2212 x 1659 pixels, 45° field of view, retinal fundus photograph:
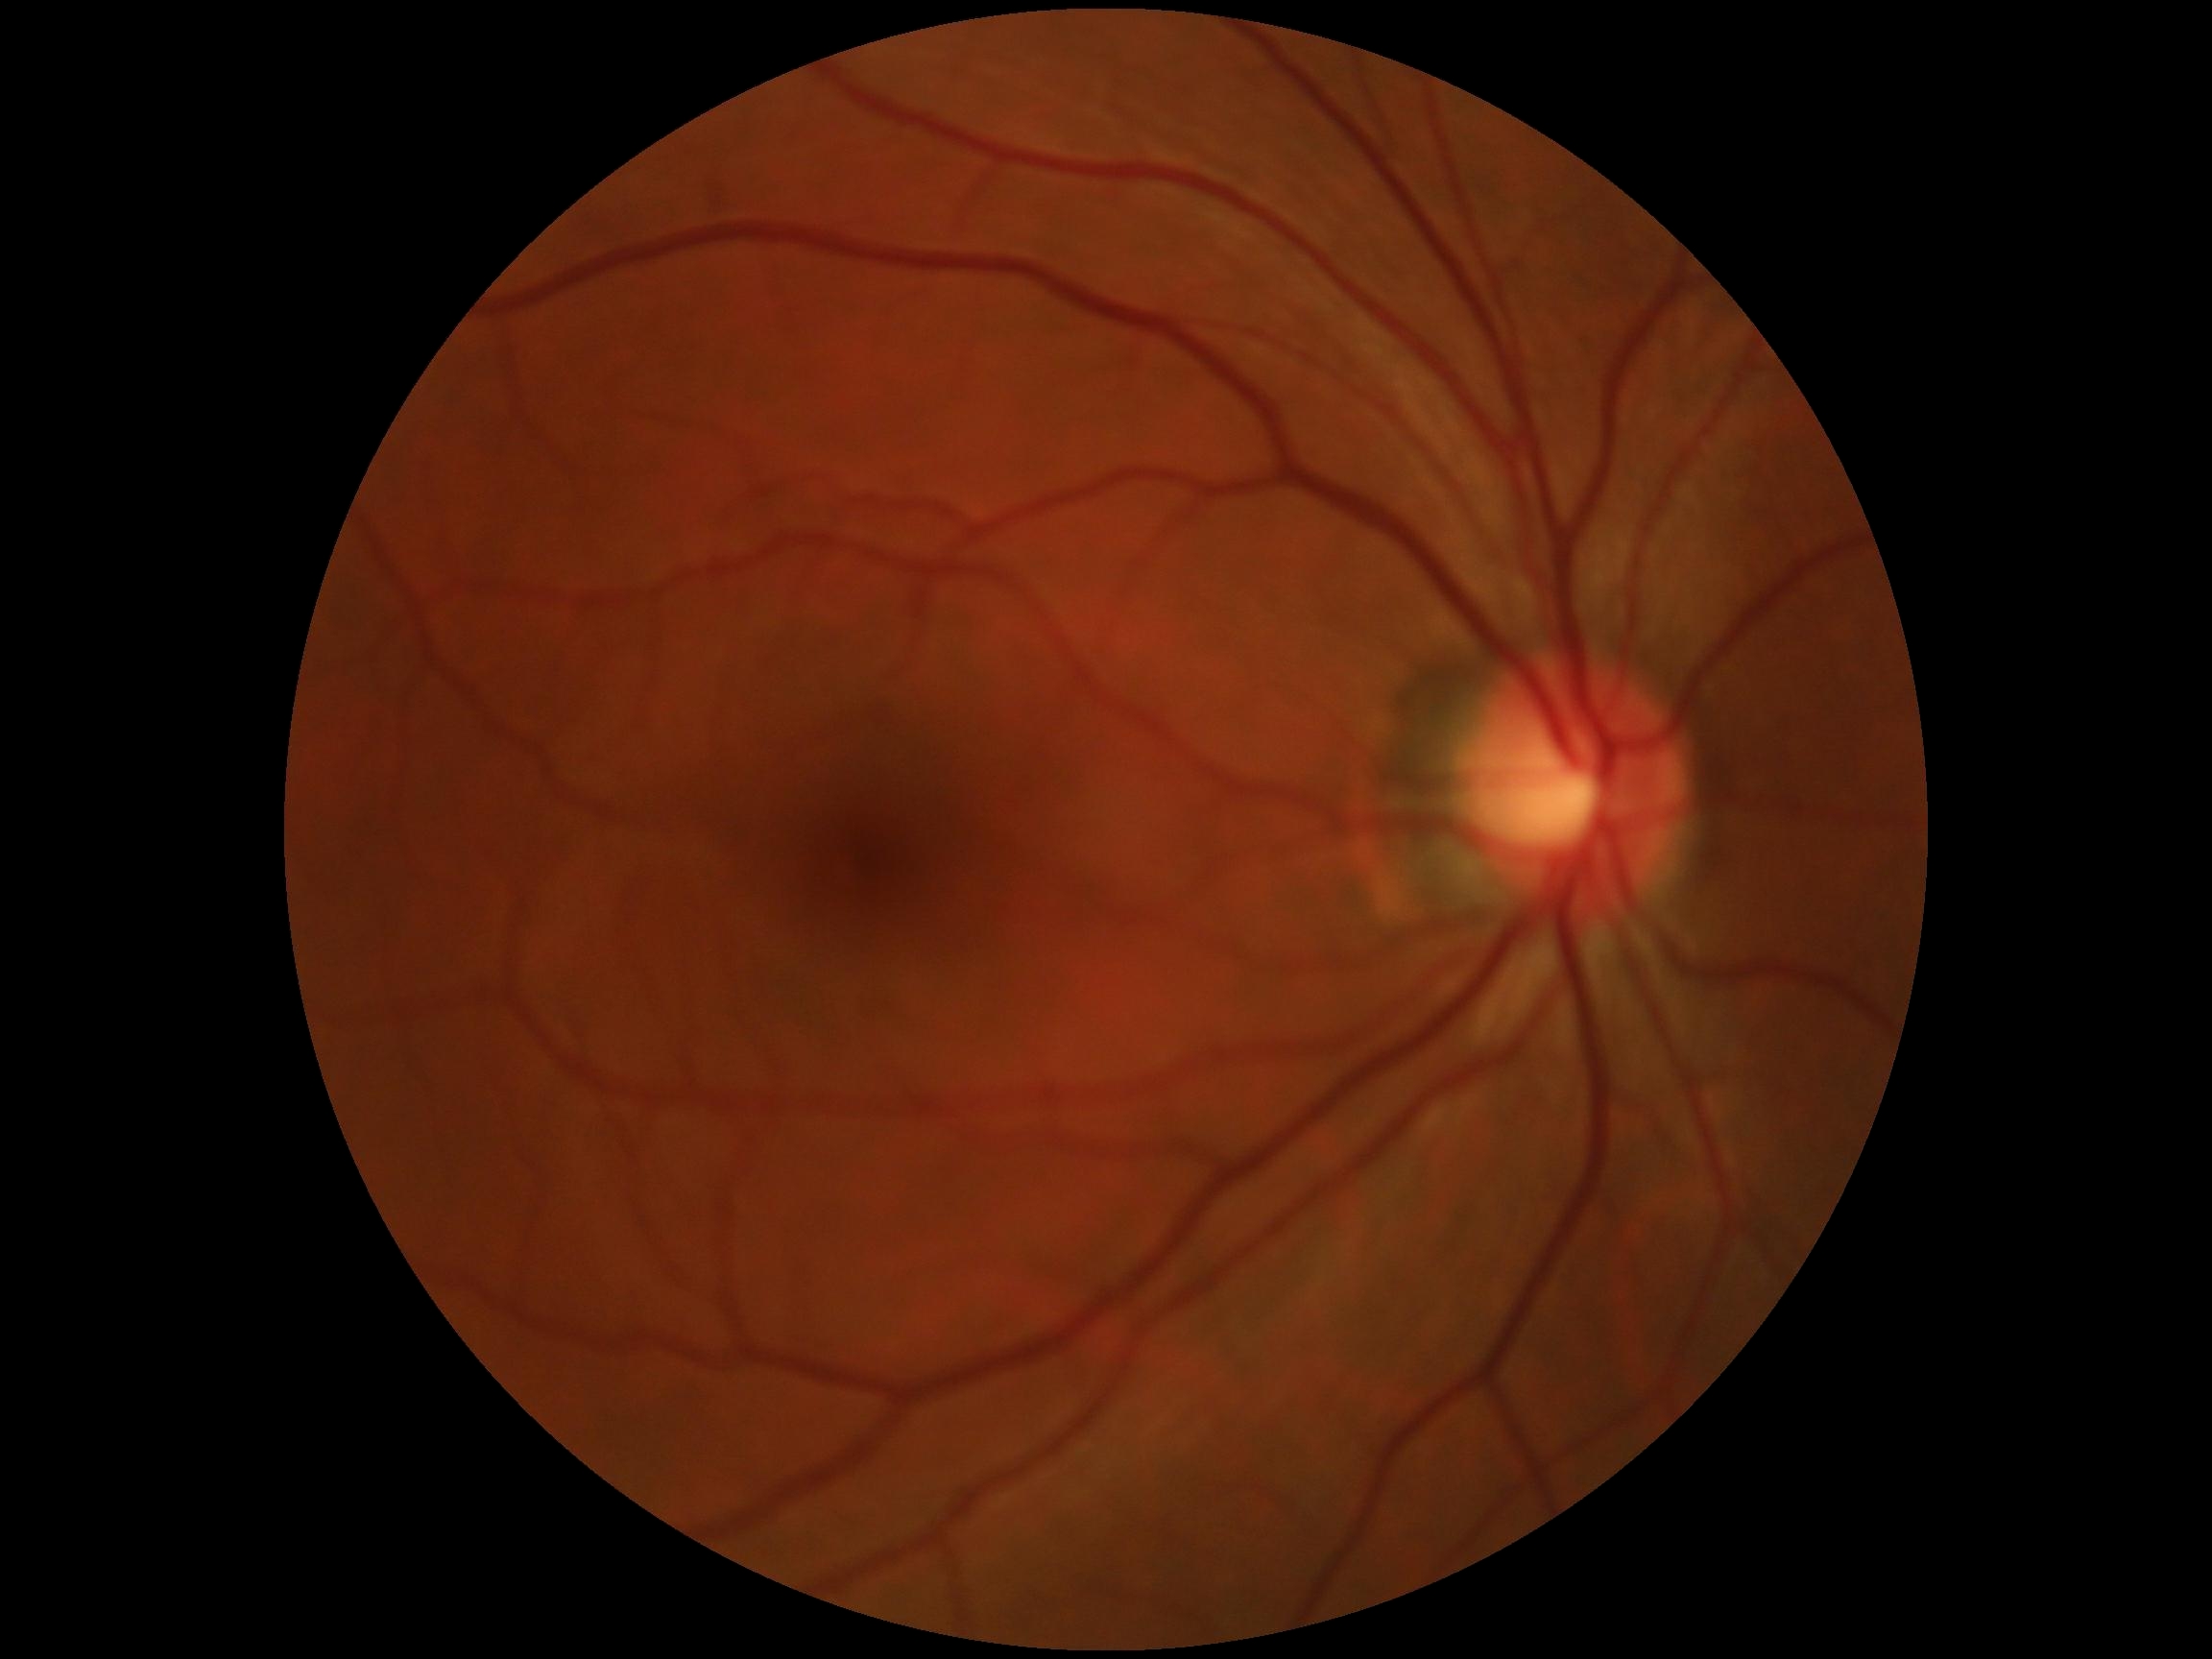 Diabetic retinopathy is 0.